Clarity RetCam 3, 130° FOV; pediatric wide-field fundus photograph: 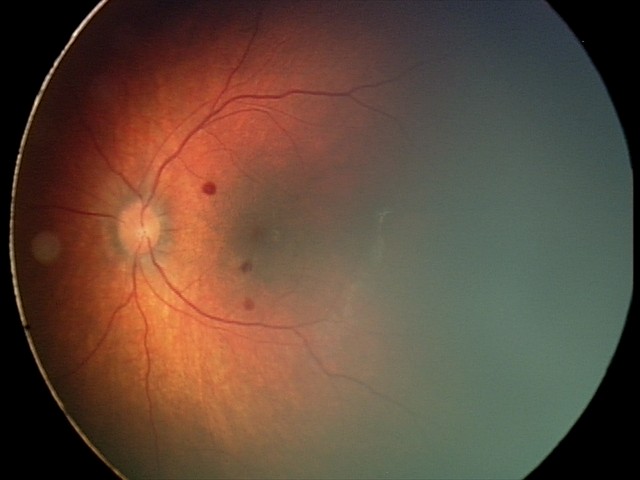
Screening series with retinal hemorrhages.